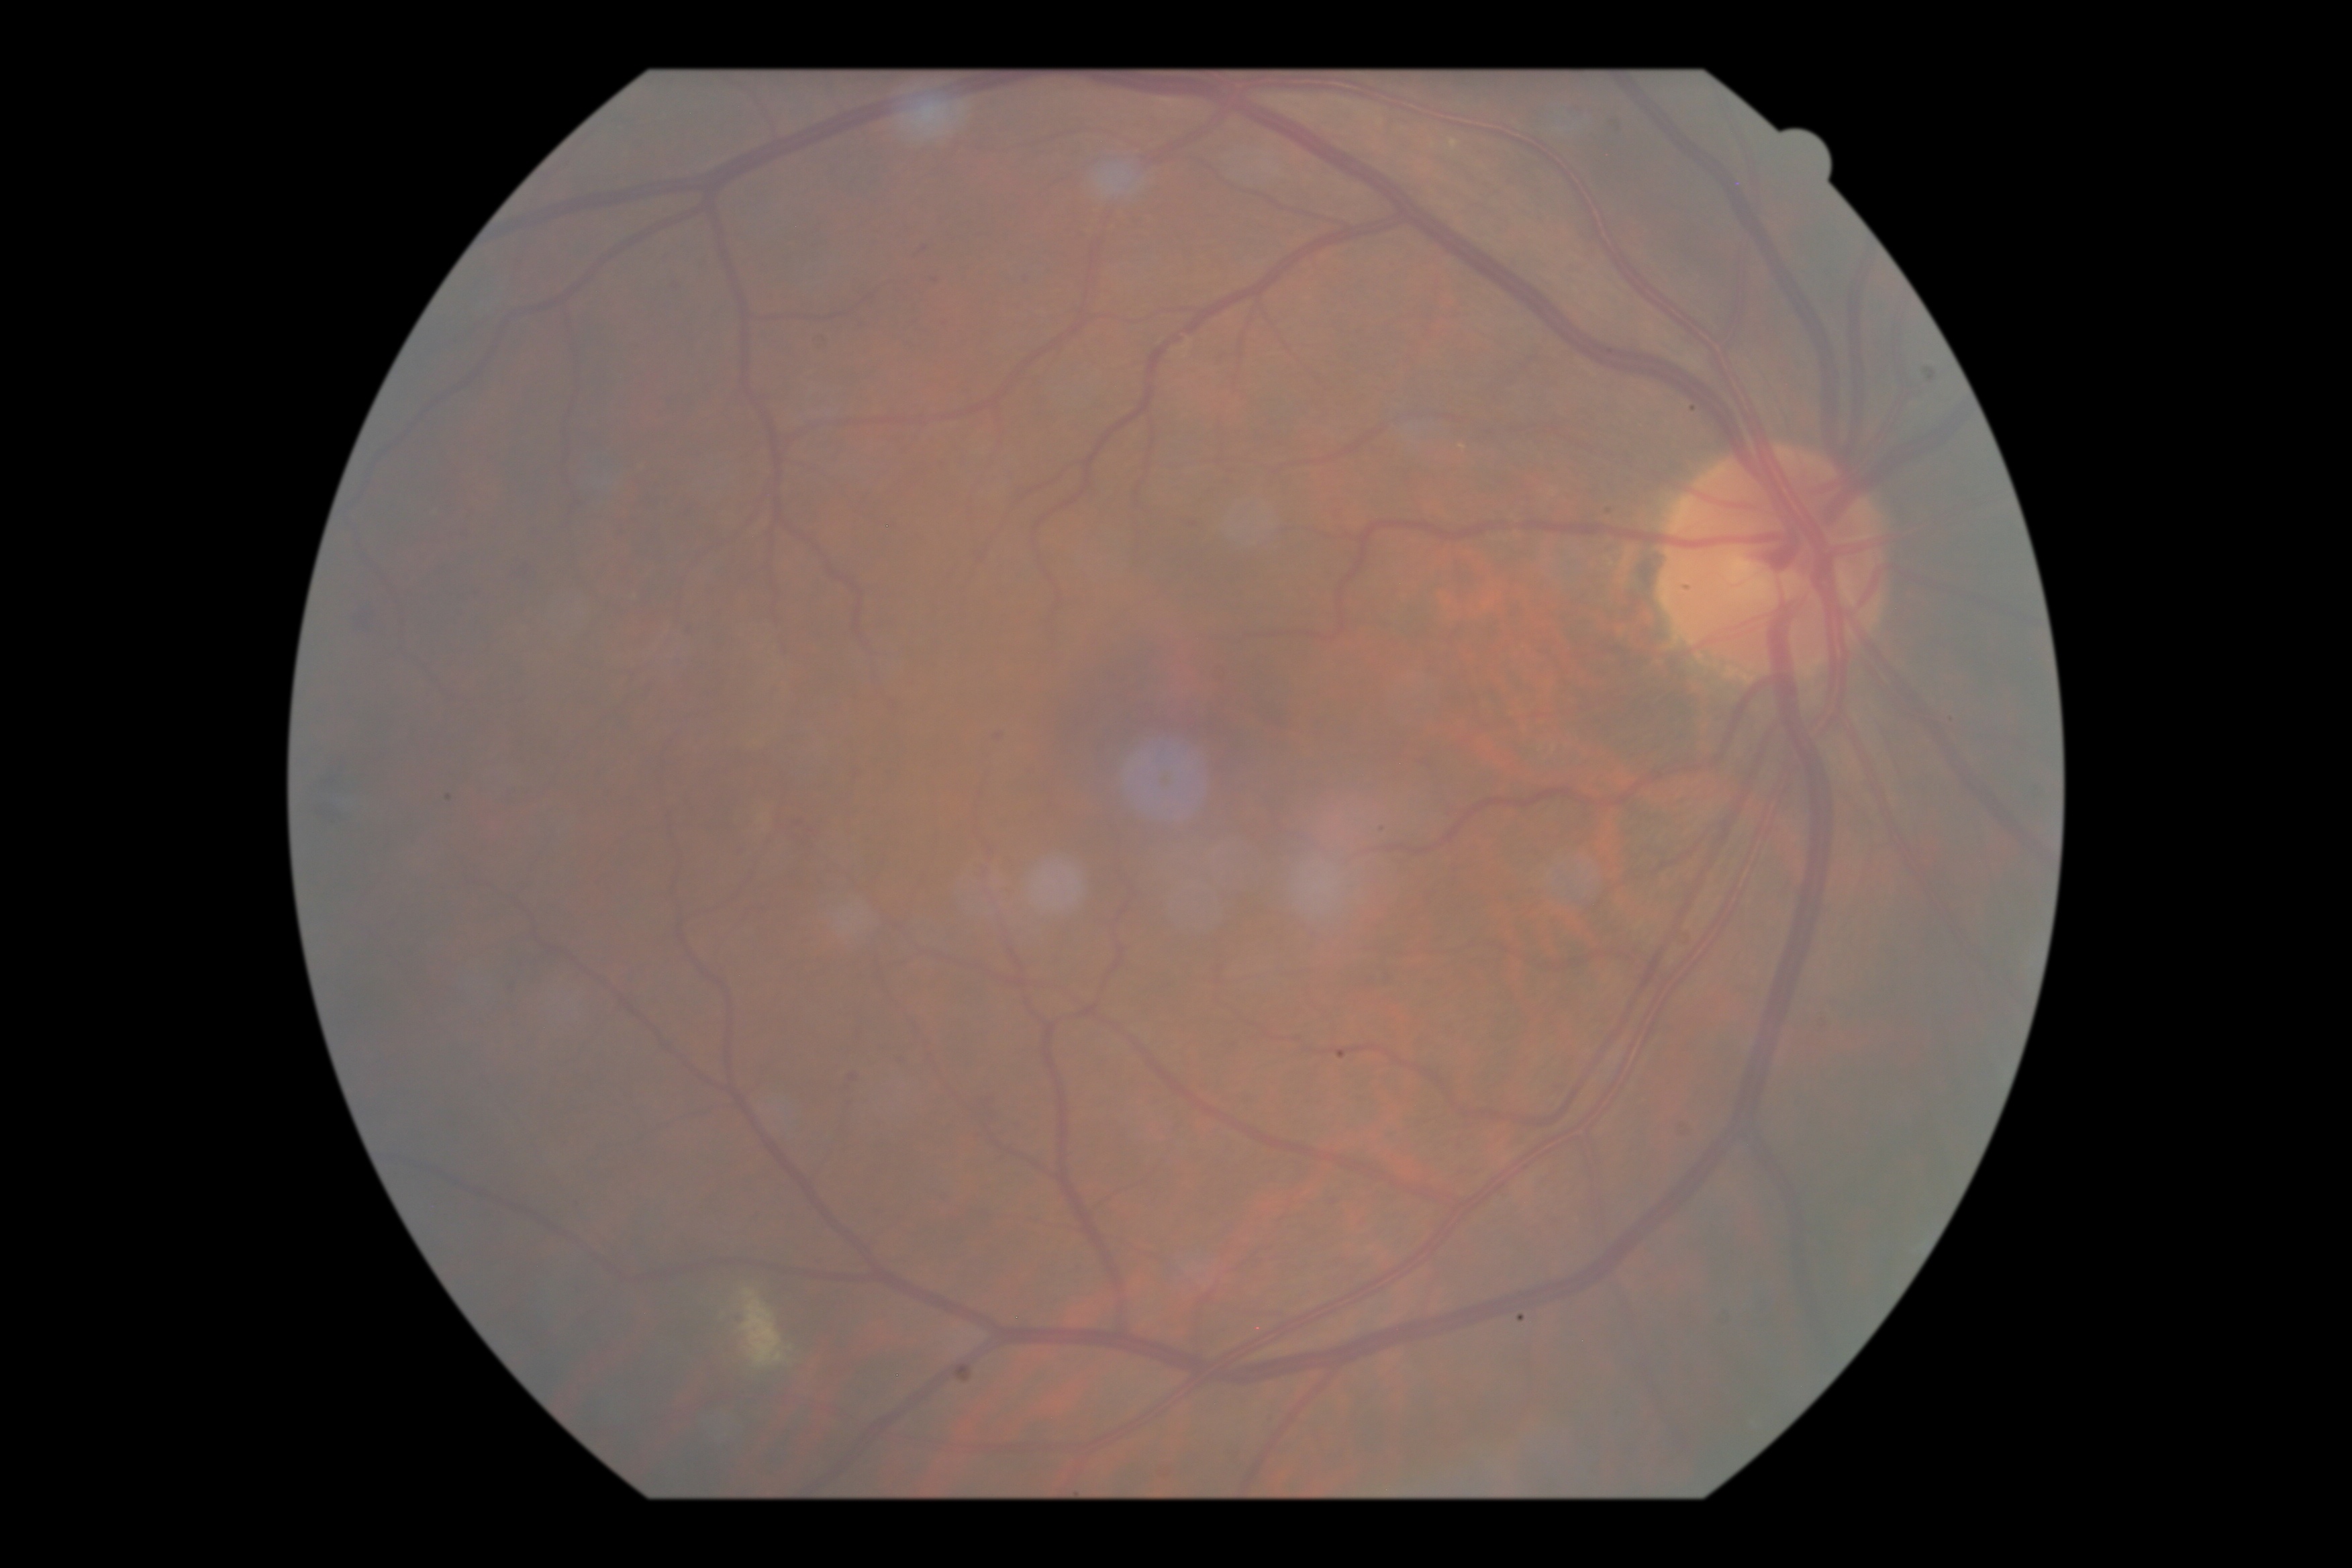 Diabetic retinopathy grade: 2.